Phoenix ICON wide-field infant fundus image
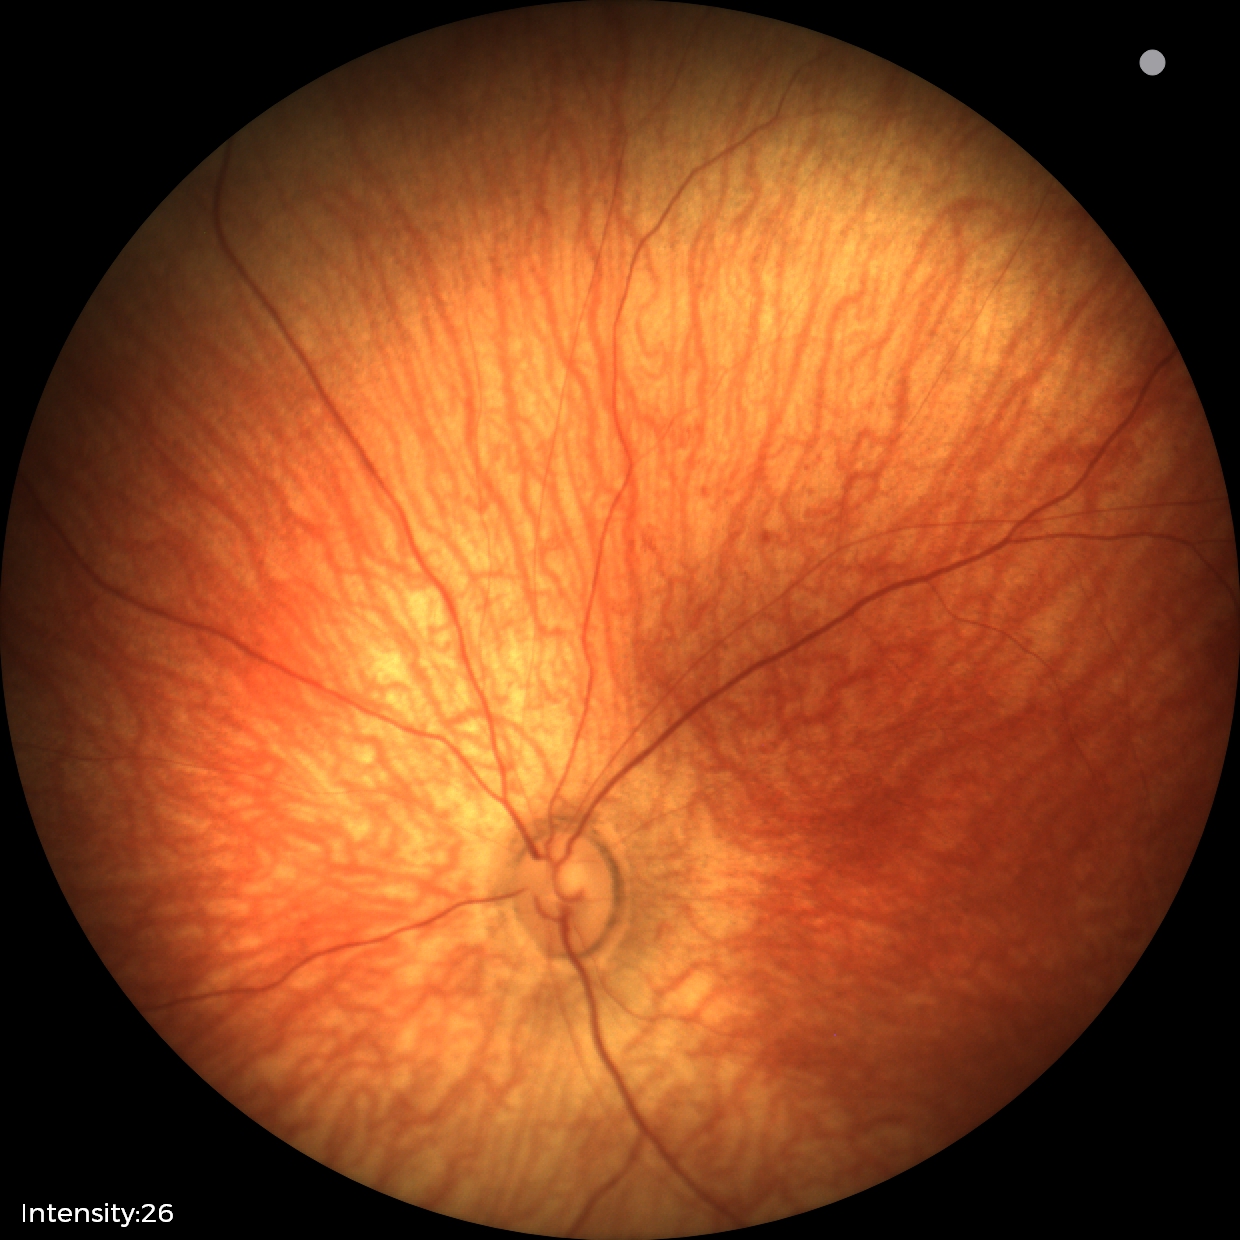 Screening diagnosis: no abnormalities.